45-degree field of view — 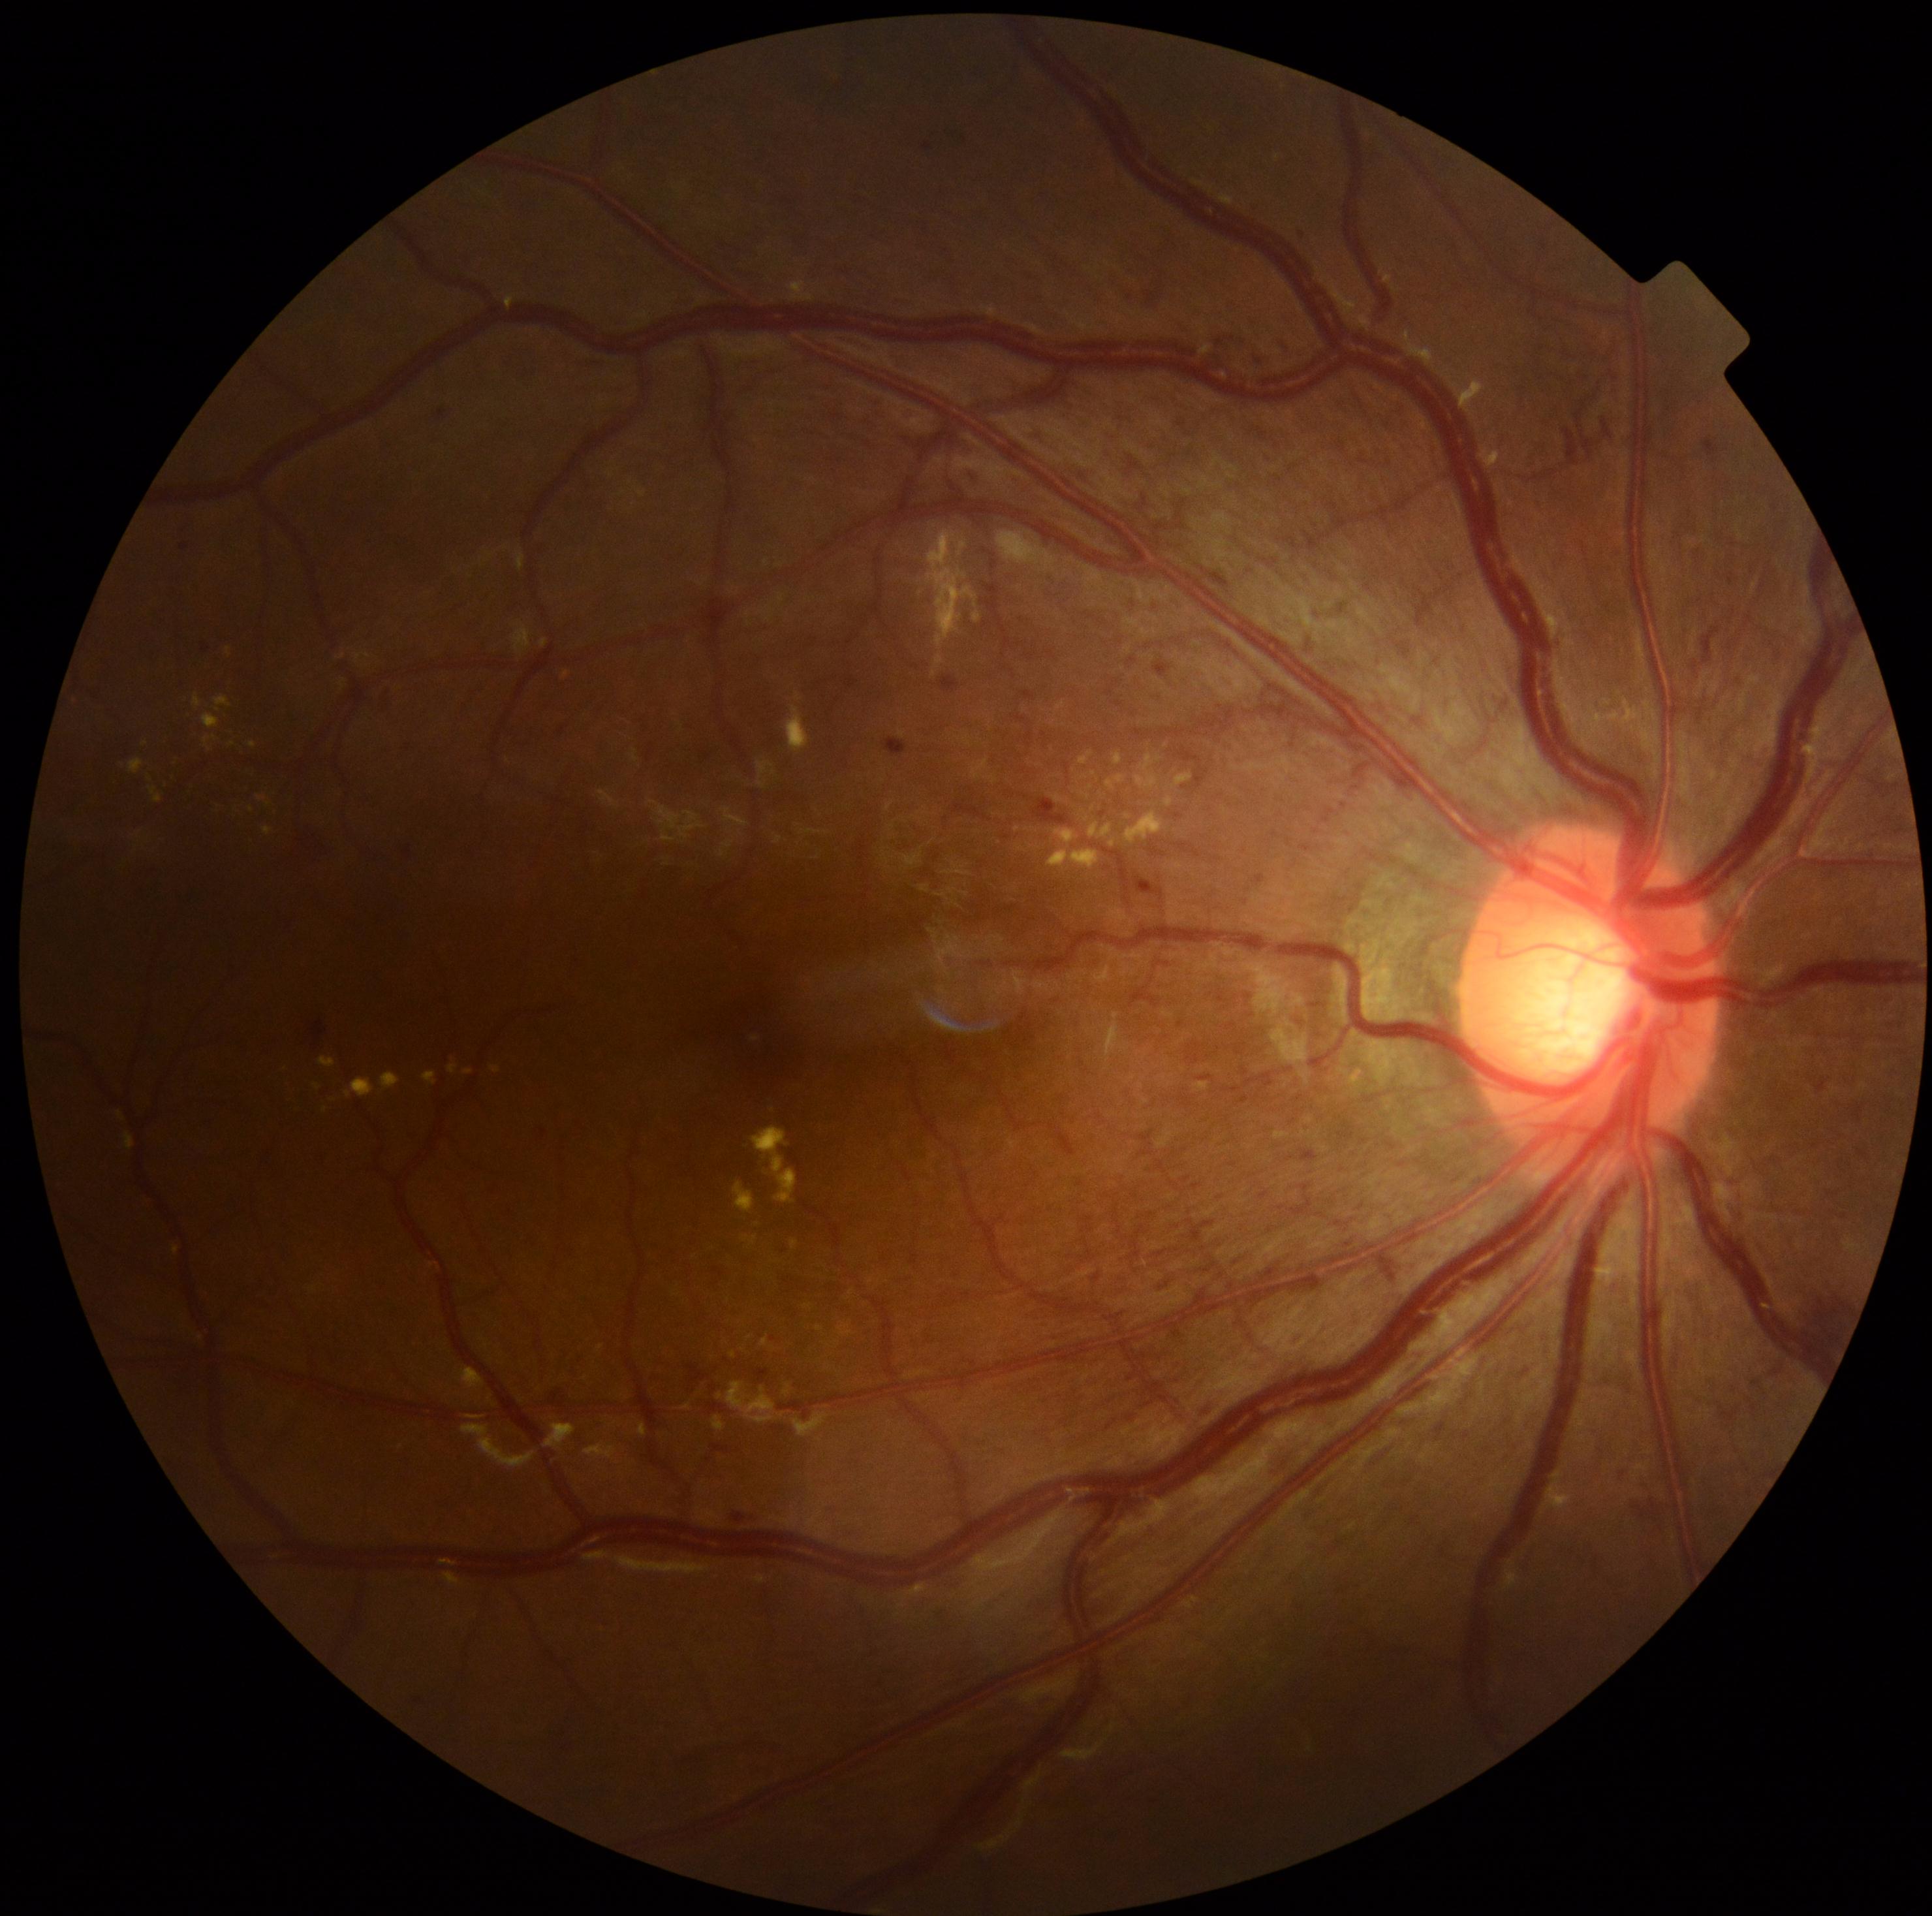
retinopathy: grade 3 (severe NPDR).